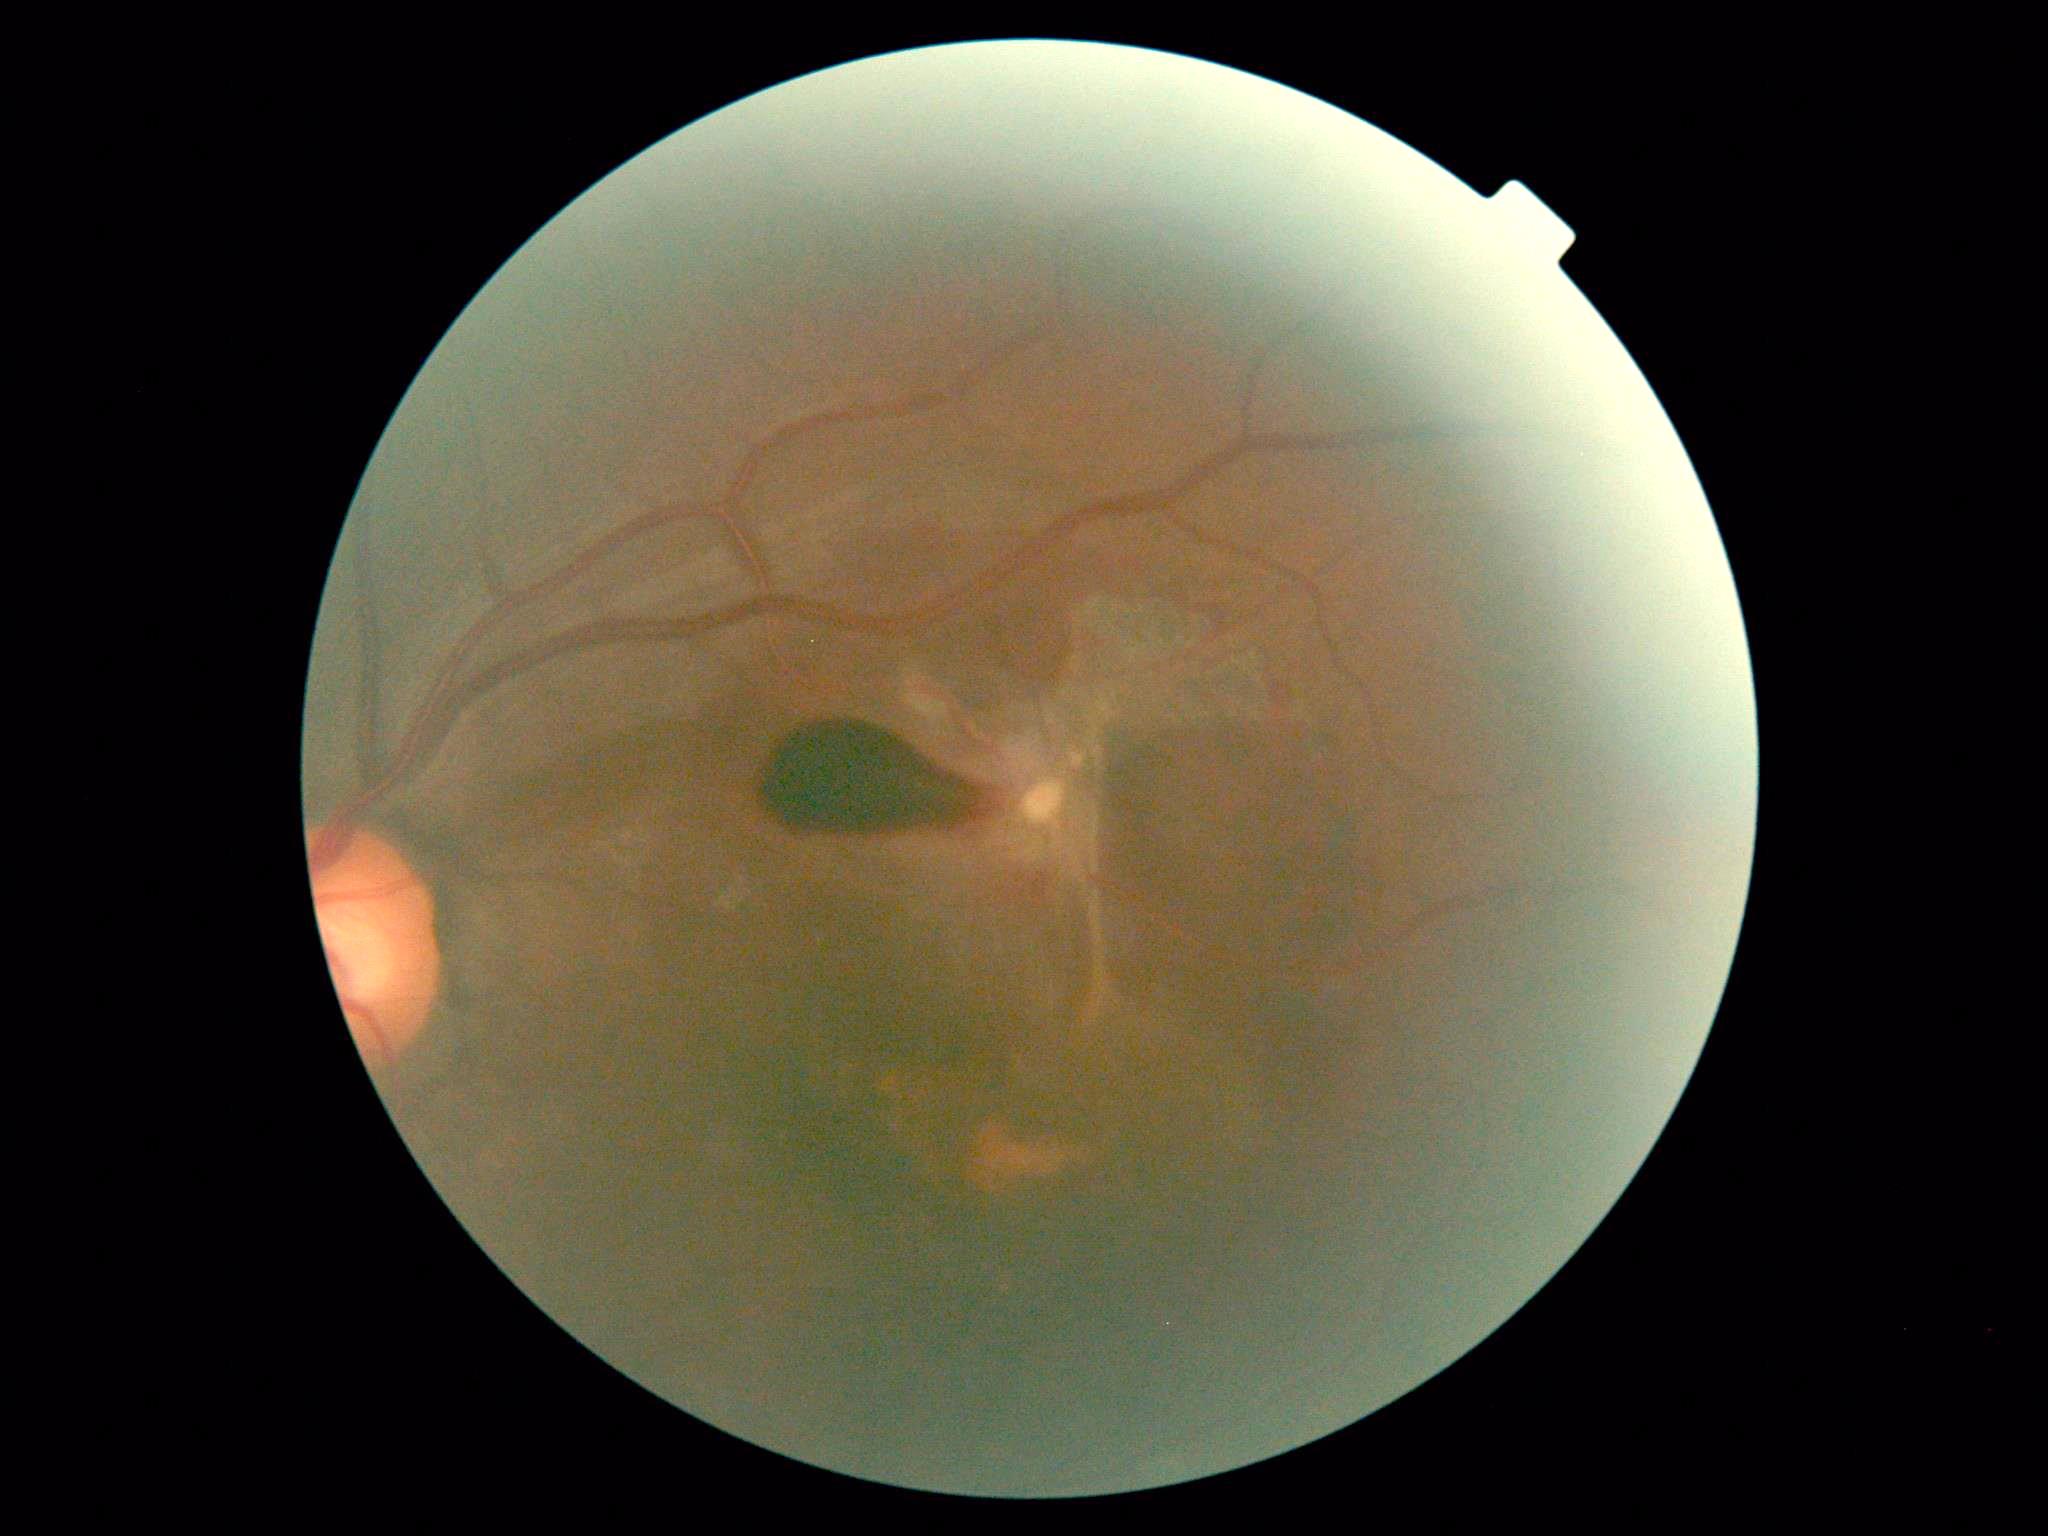 {
  "dr_grade": "4/4 — neovascularization and/or vitreous/pre-retinal hemorrhage"
}